Color fundus image
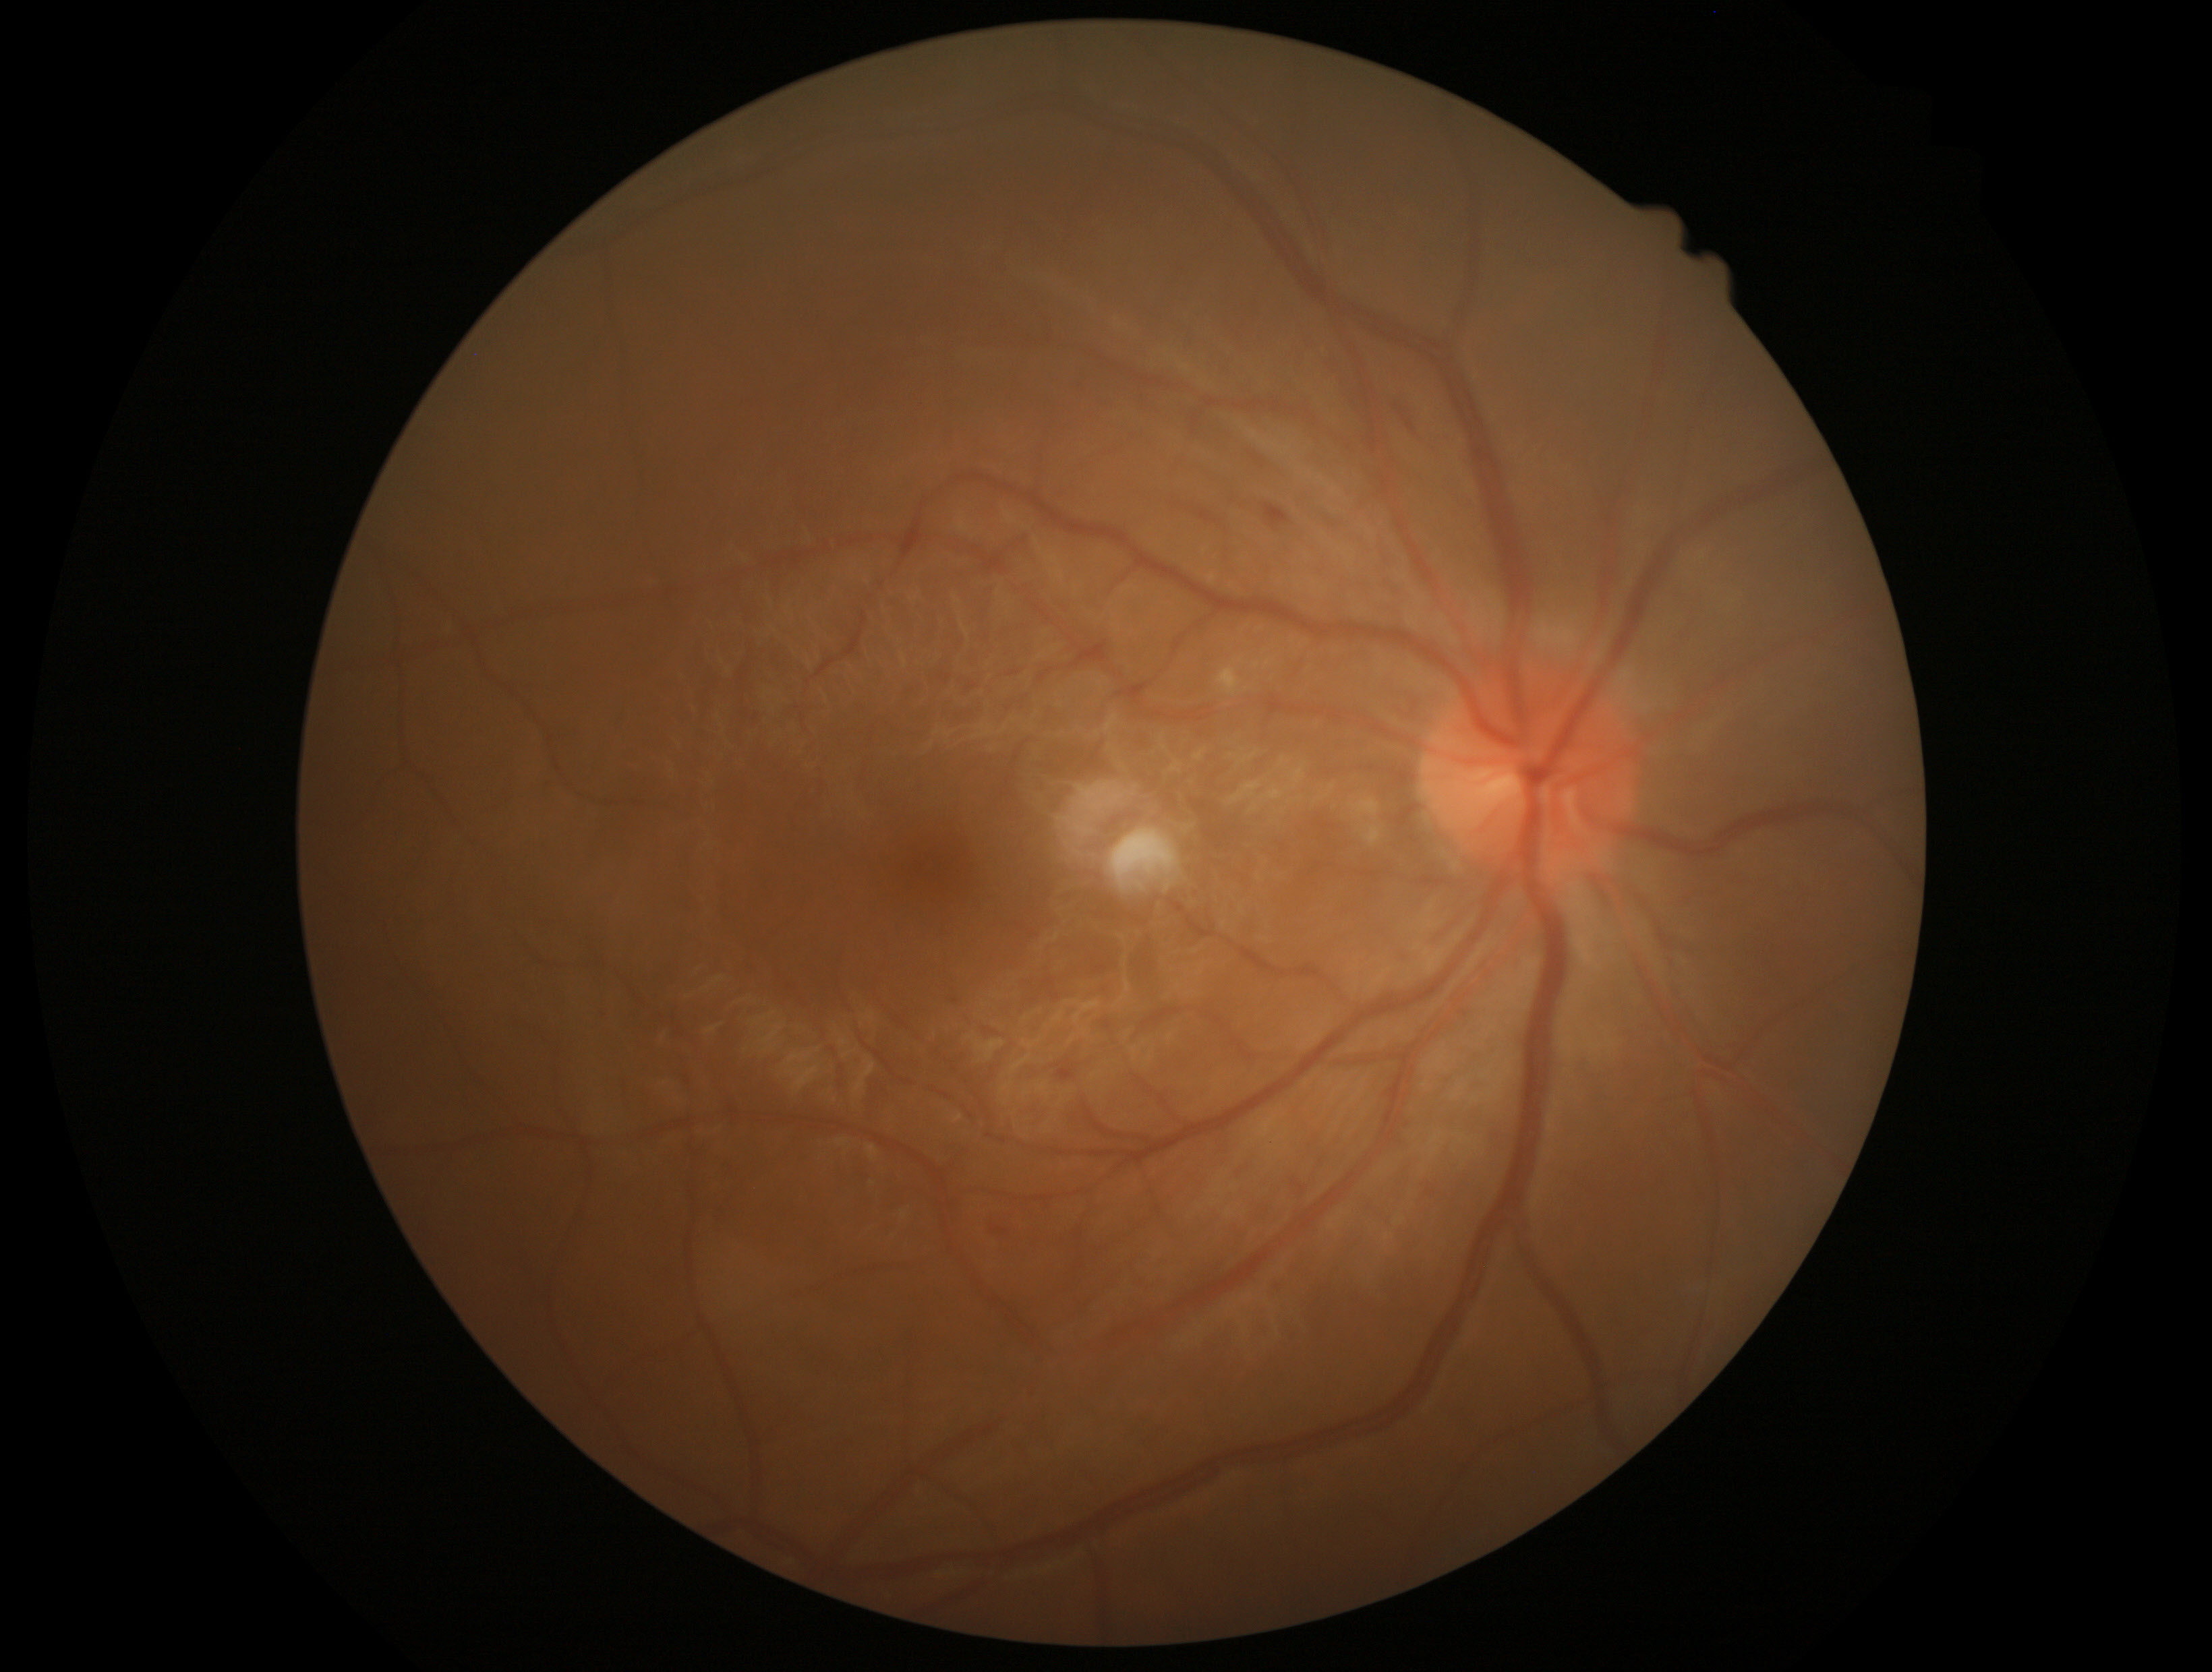 Diabetic retinopathy (DR): moderate non-proliferative diabetic retinopathy (grade 2) — more than just microaneurysms but less than severe NPDR.